Posterior pole color fundus photograph; nonmydriatic:
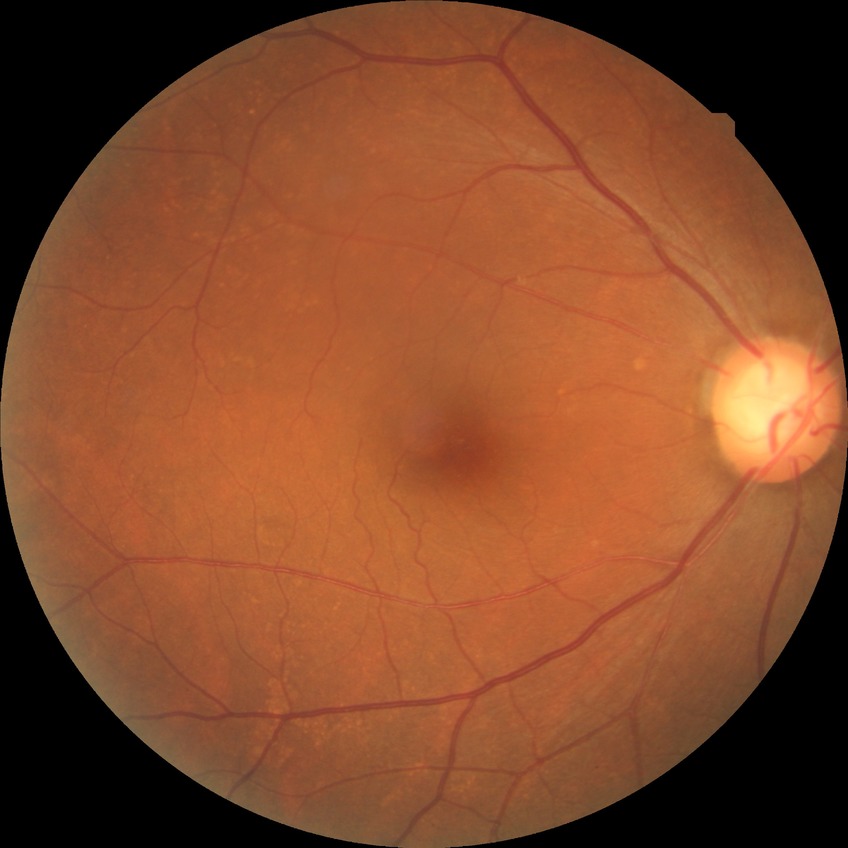
Diabetic retinopathy (DR): NDR (no diabetic retinopathy).